CFP; 45° field of view.
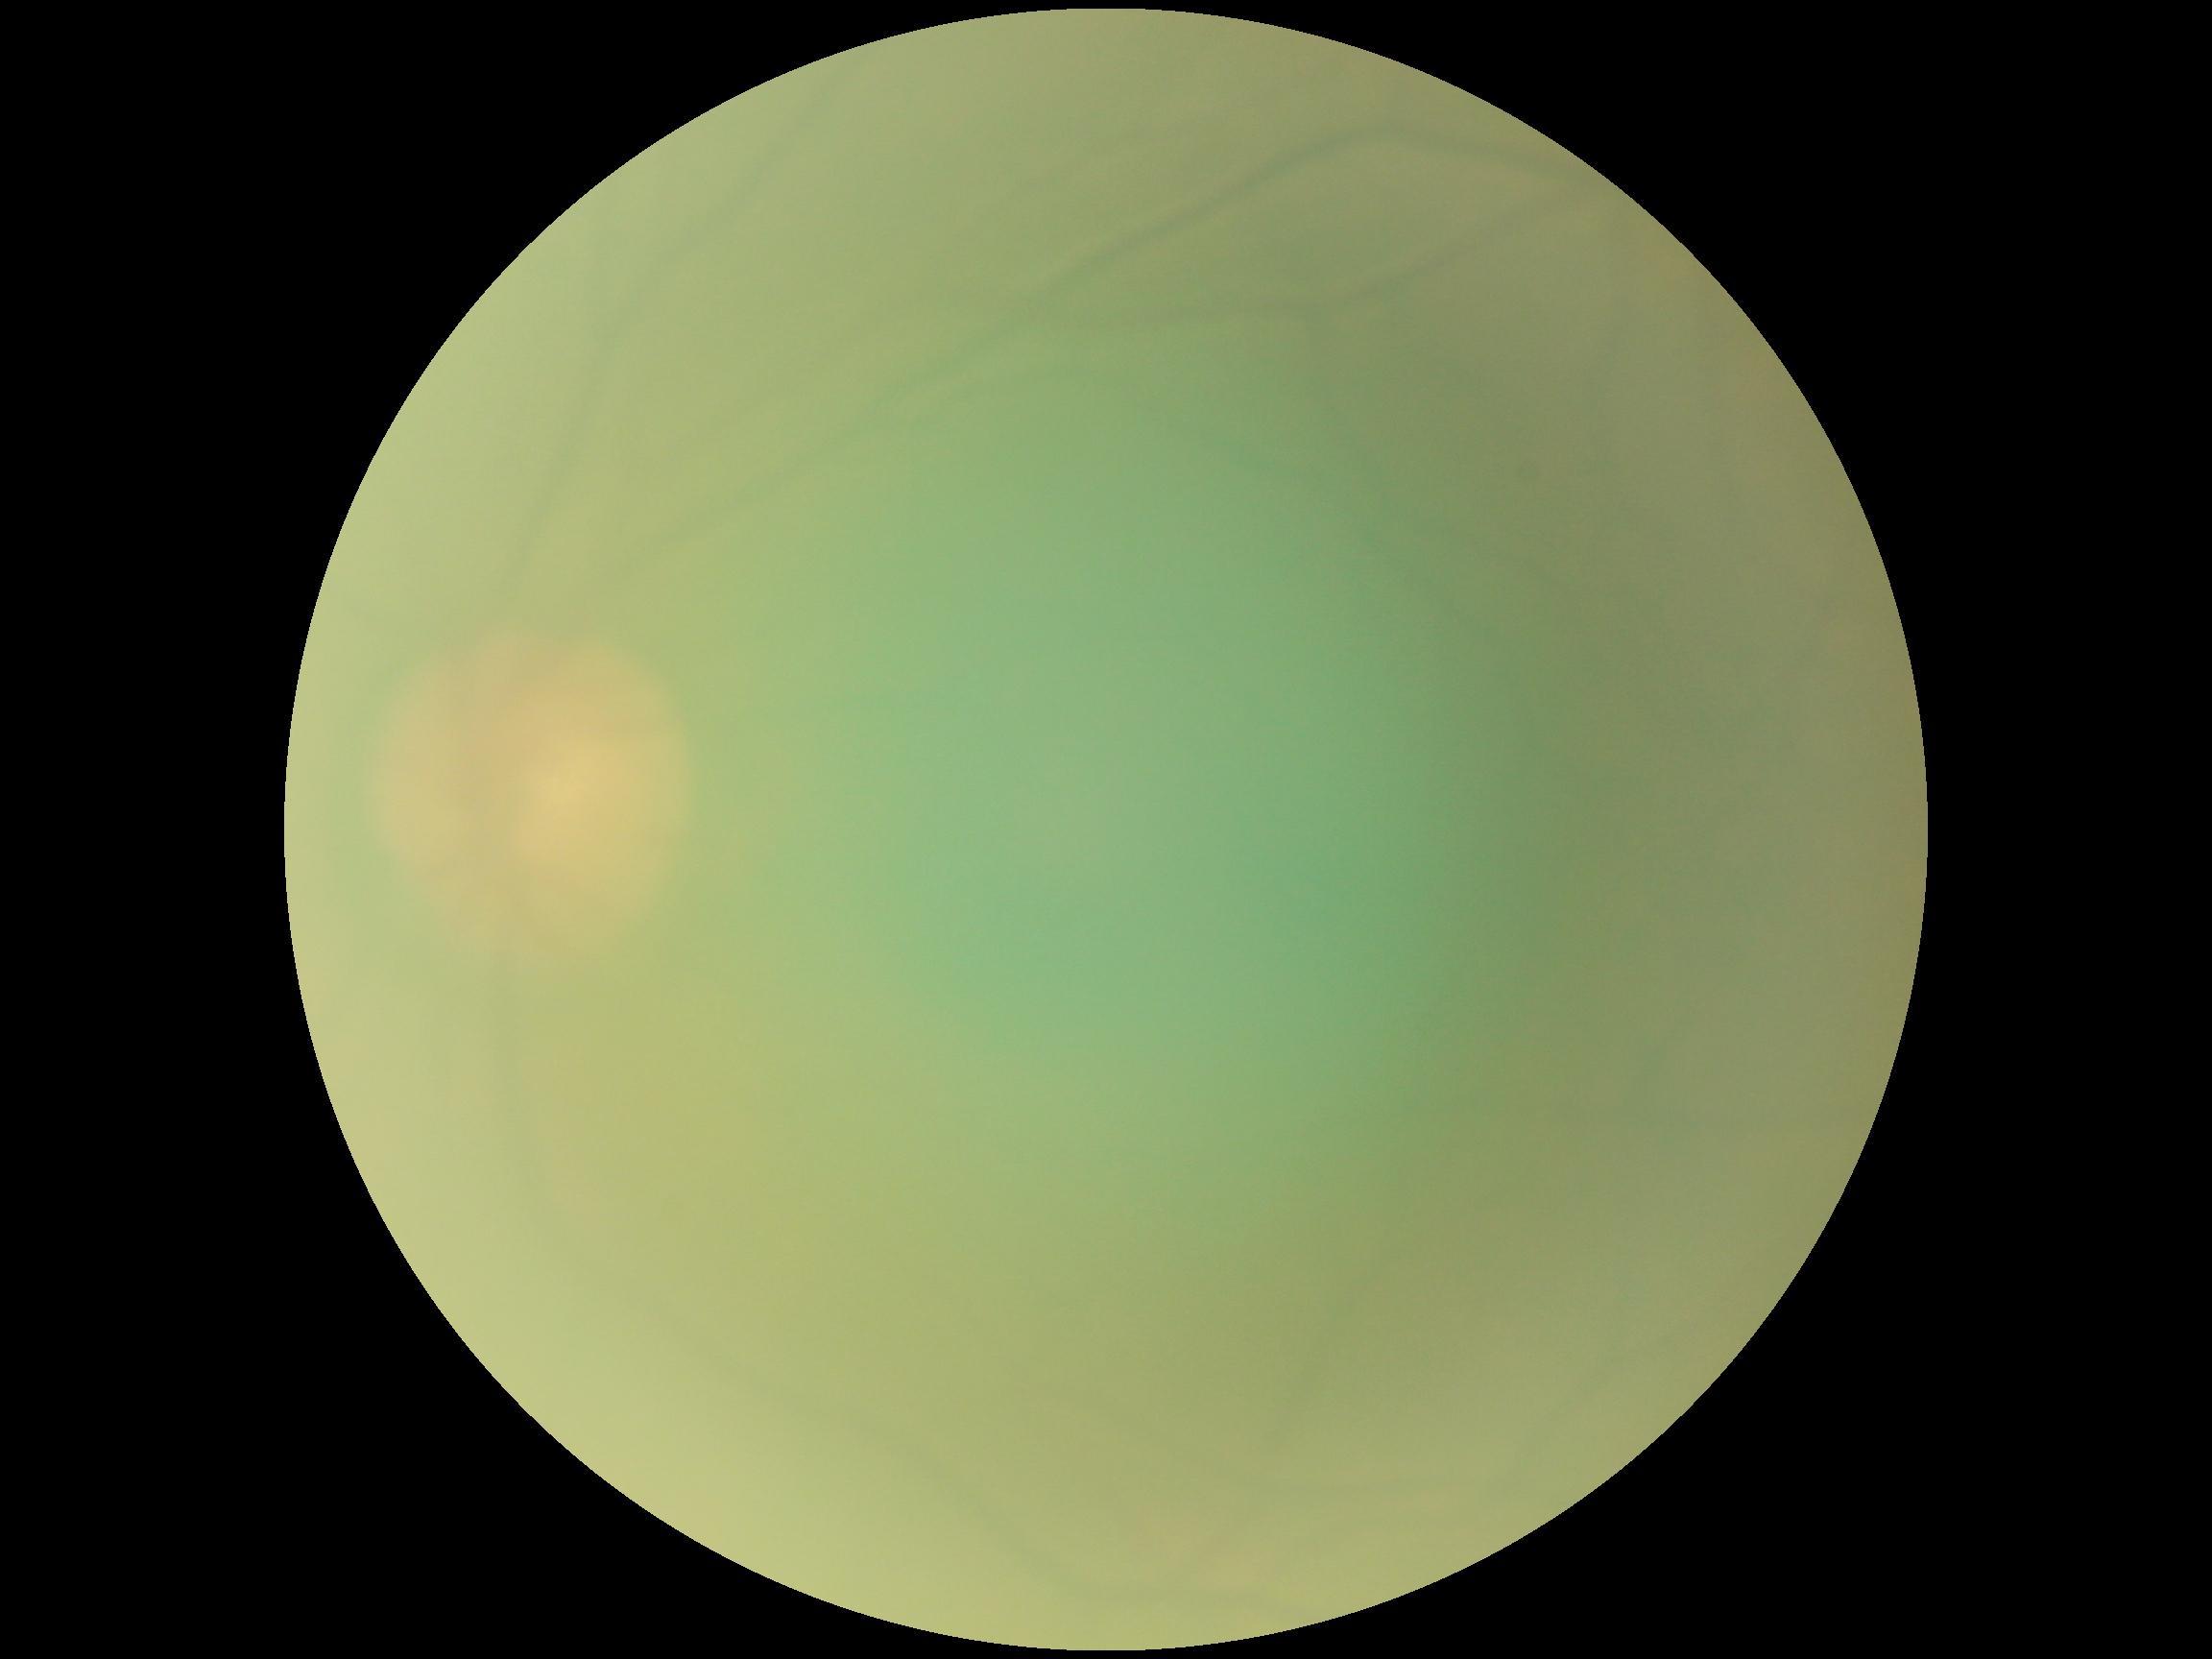
retinopathy = ungradable
image quality = too poor for DR grading